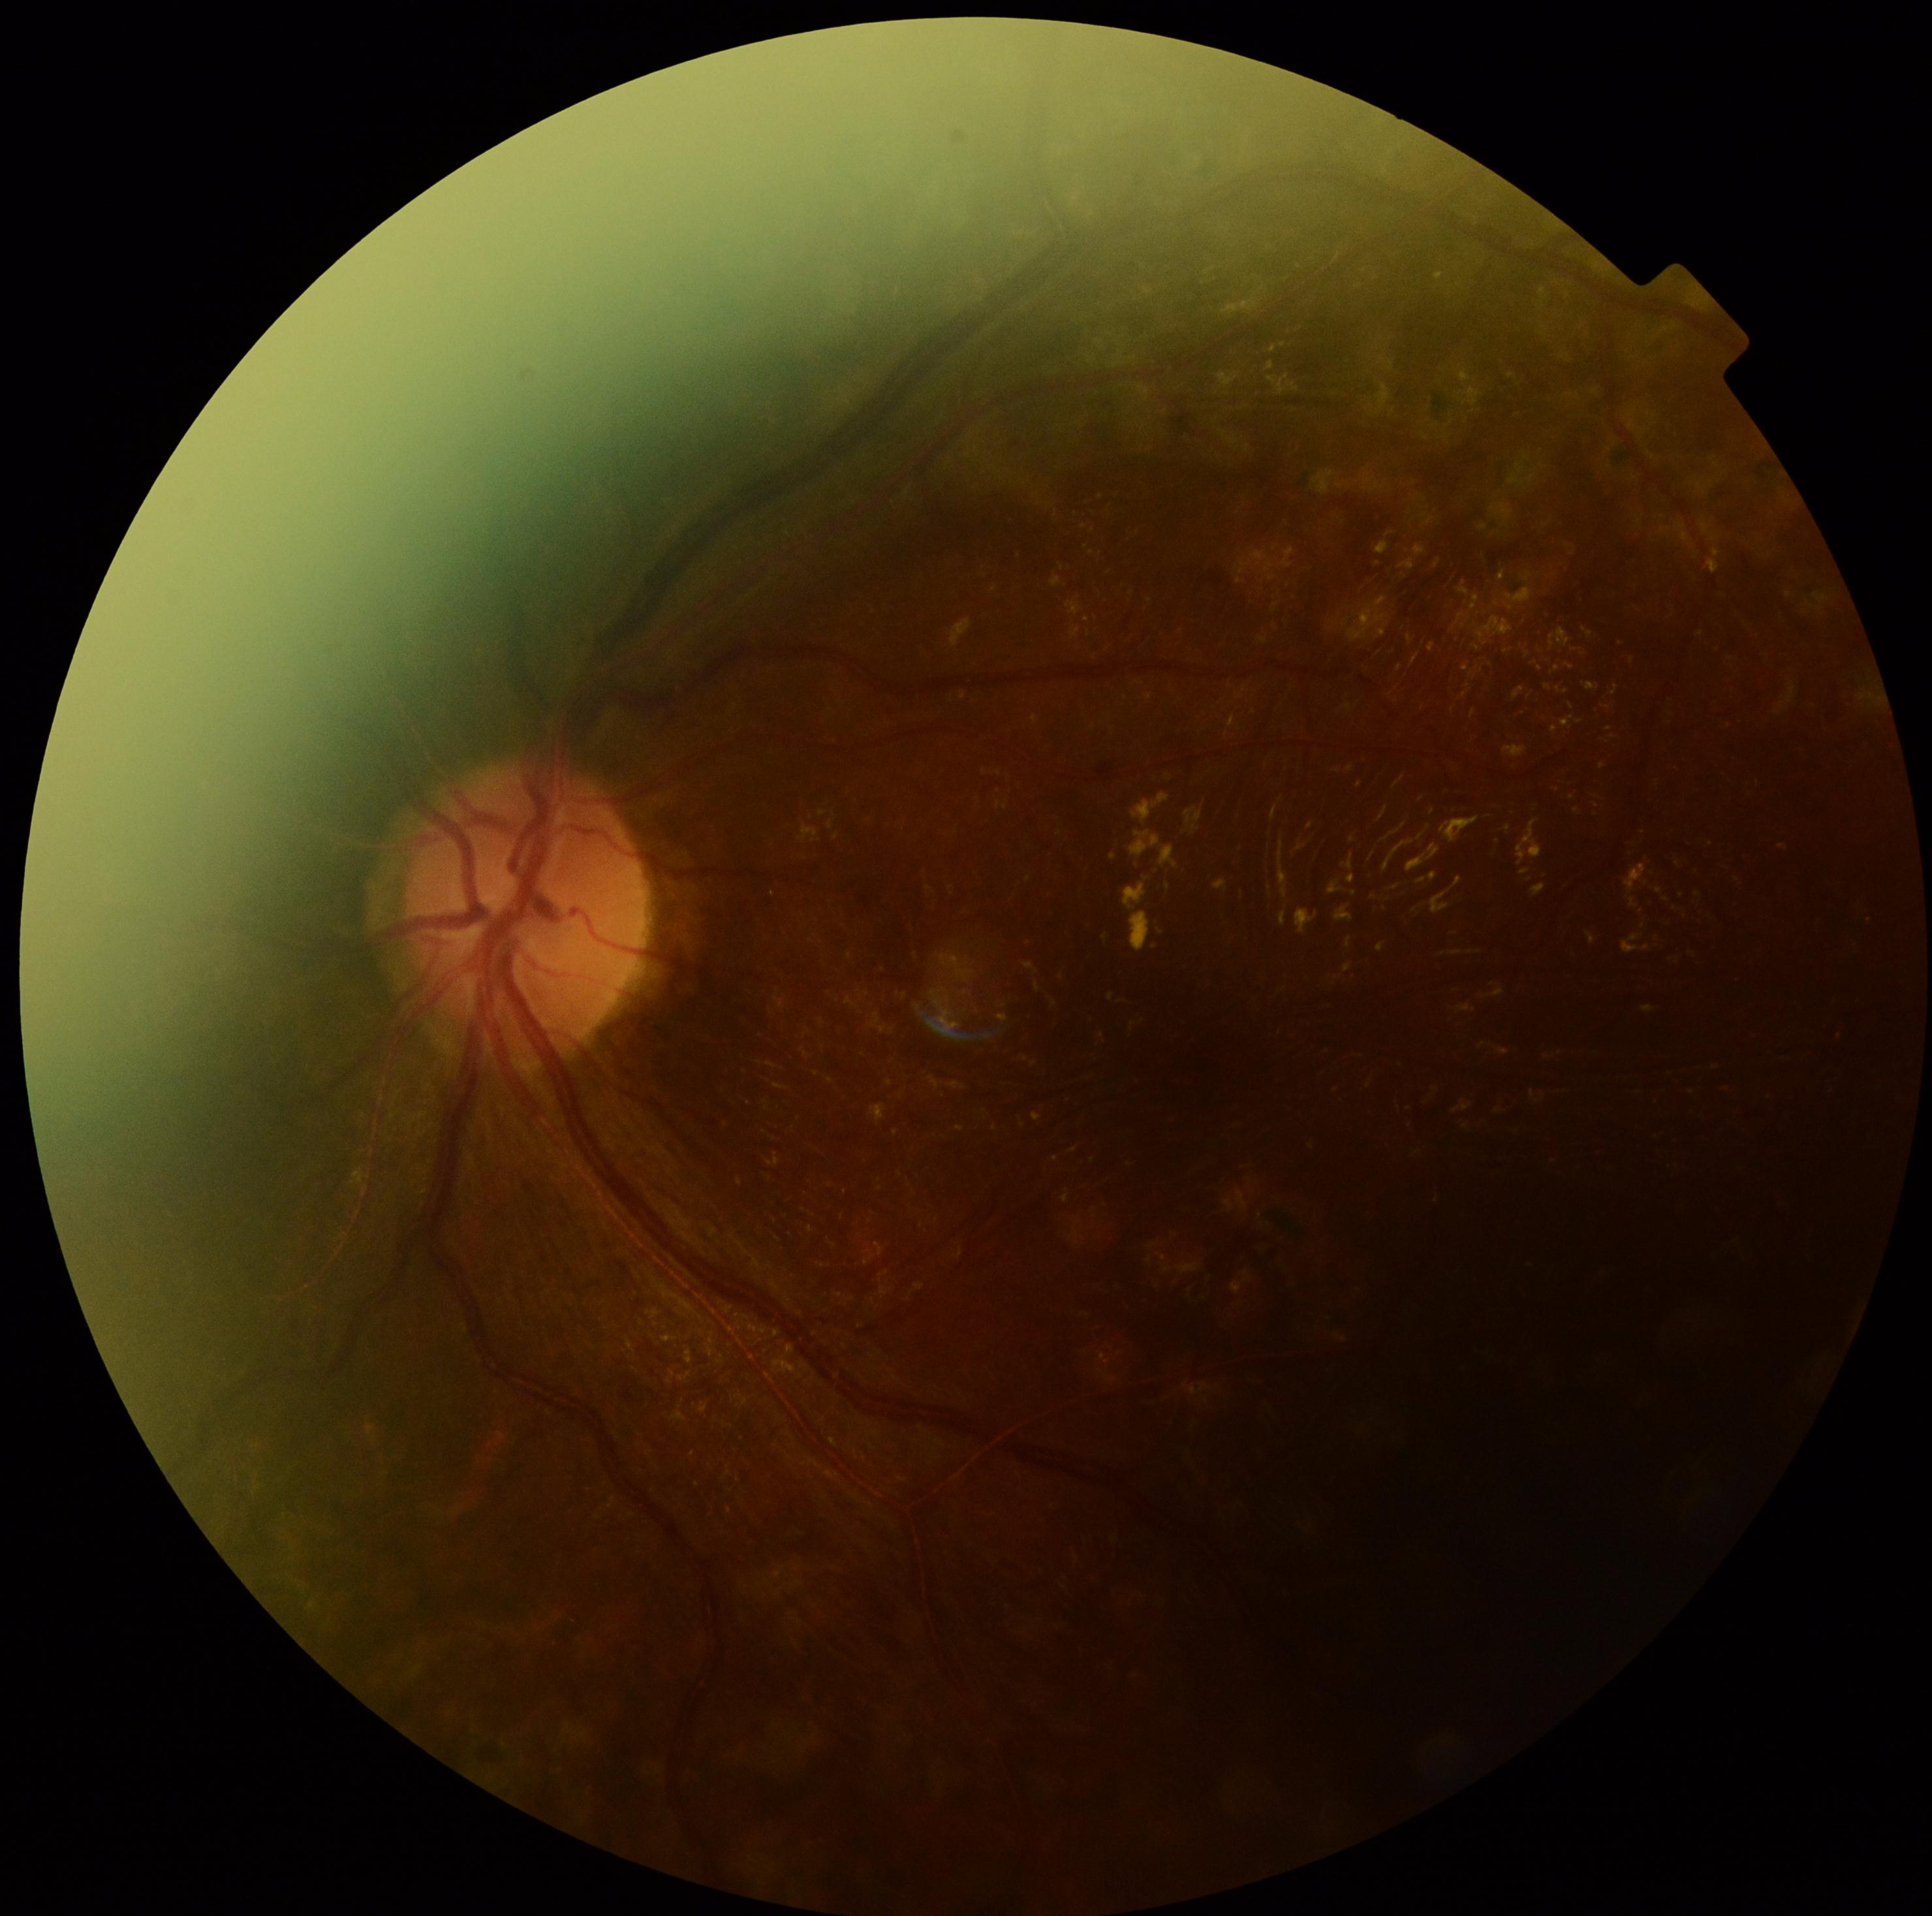
Annotations:
• DR grade: 2/4